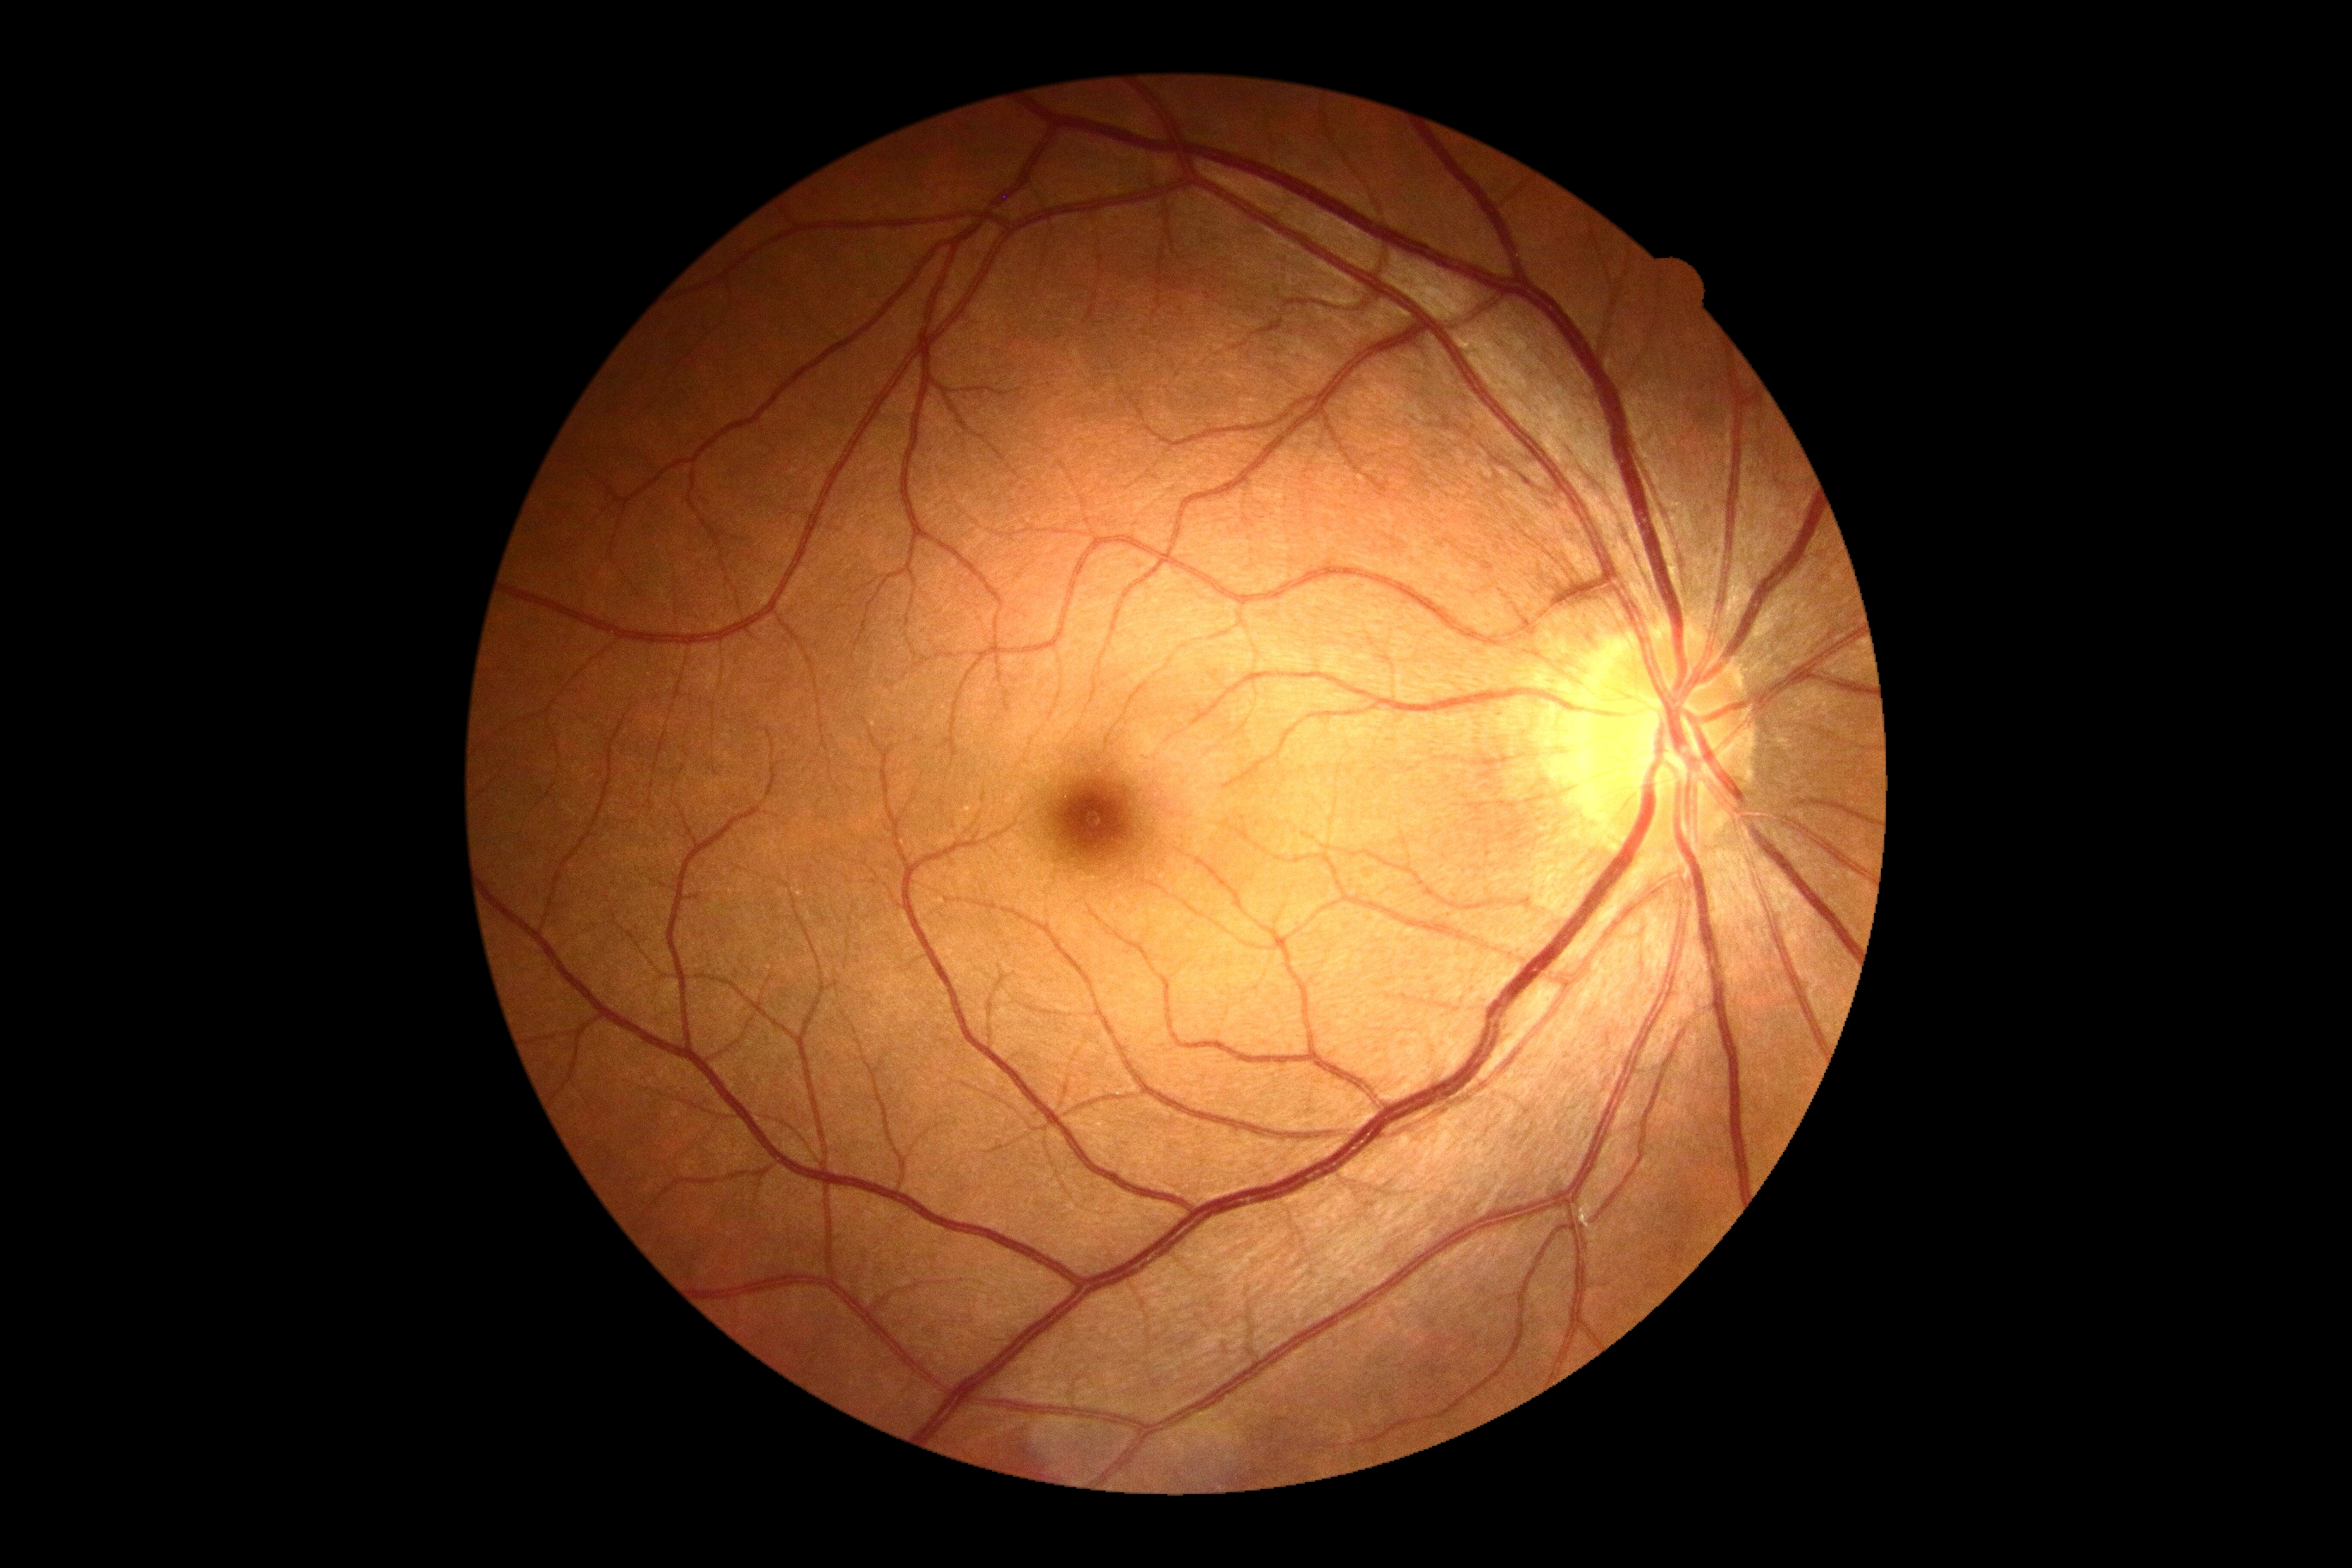

DR impression=no DR findings; retinopathy=no apparent diabetic retinopathy (grade 0).